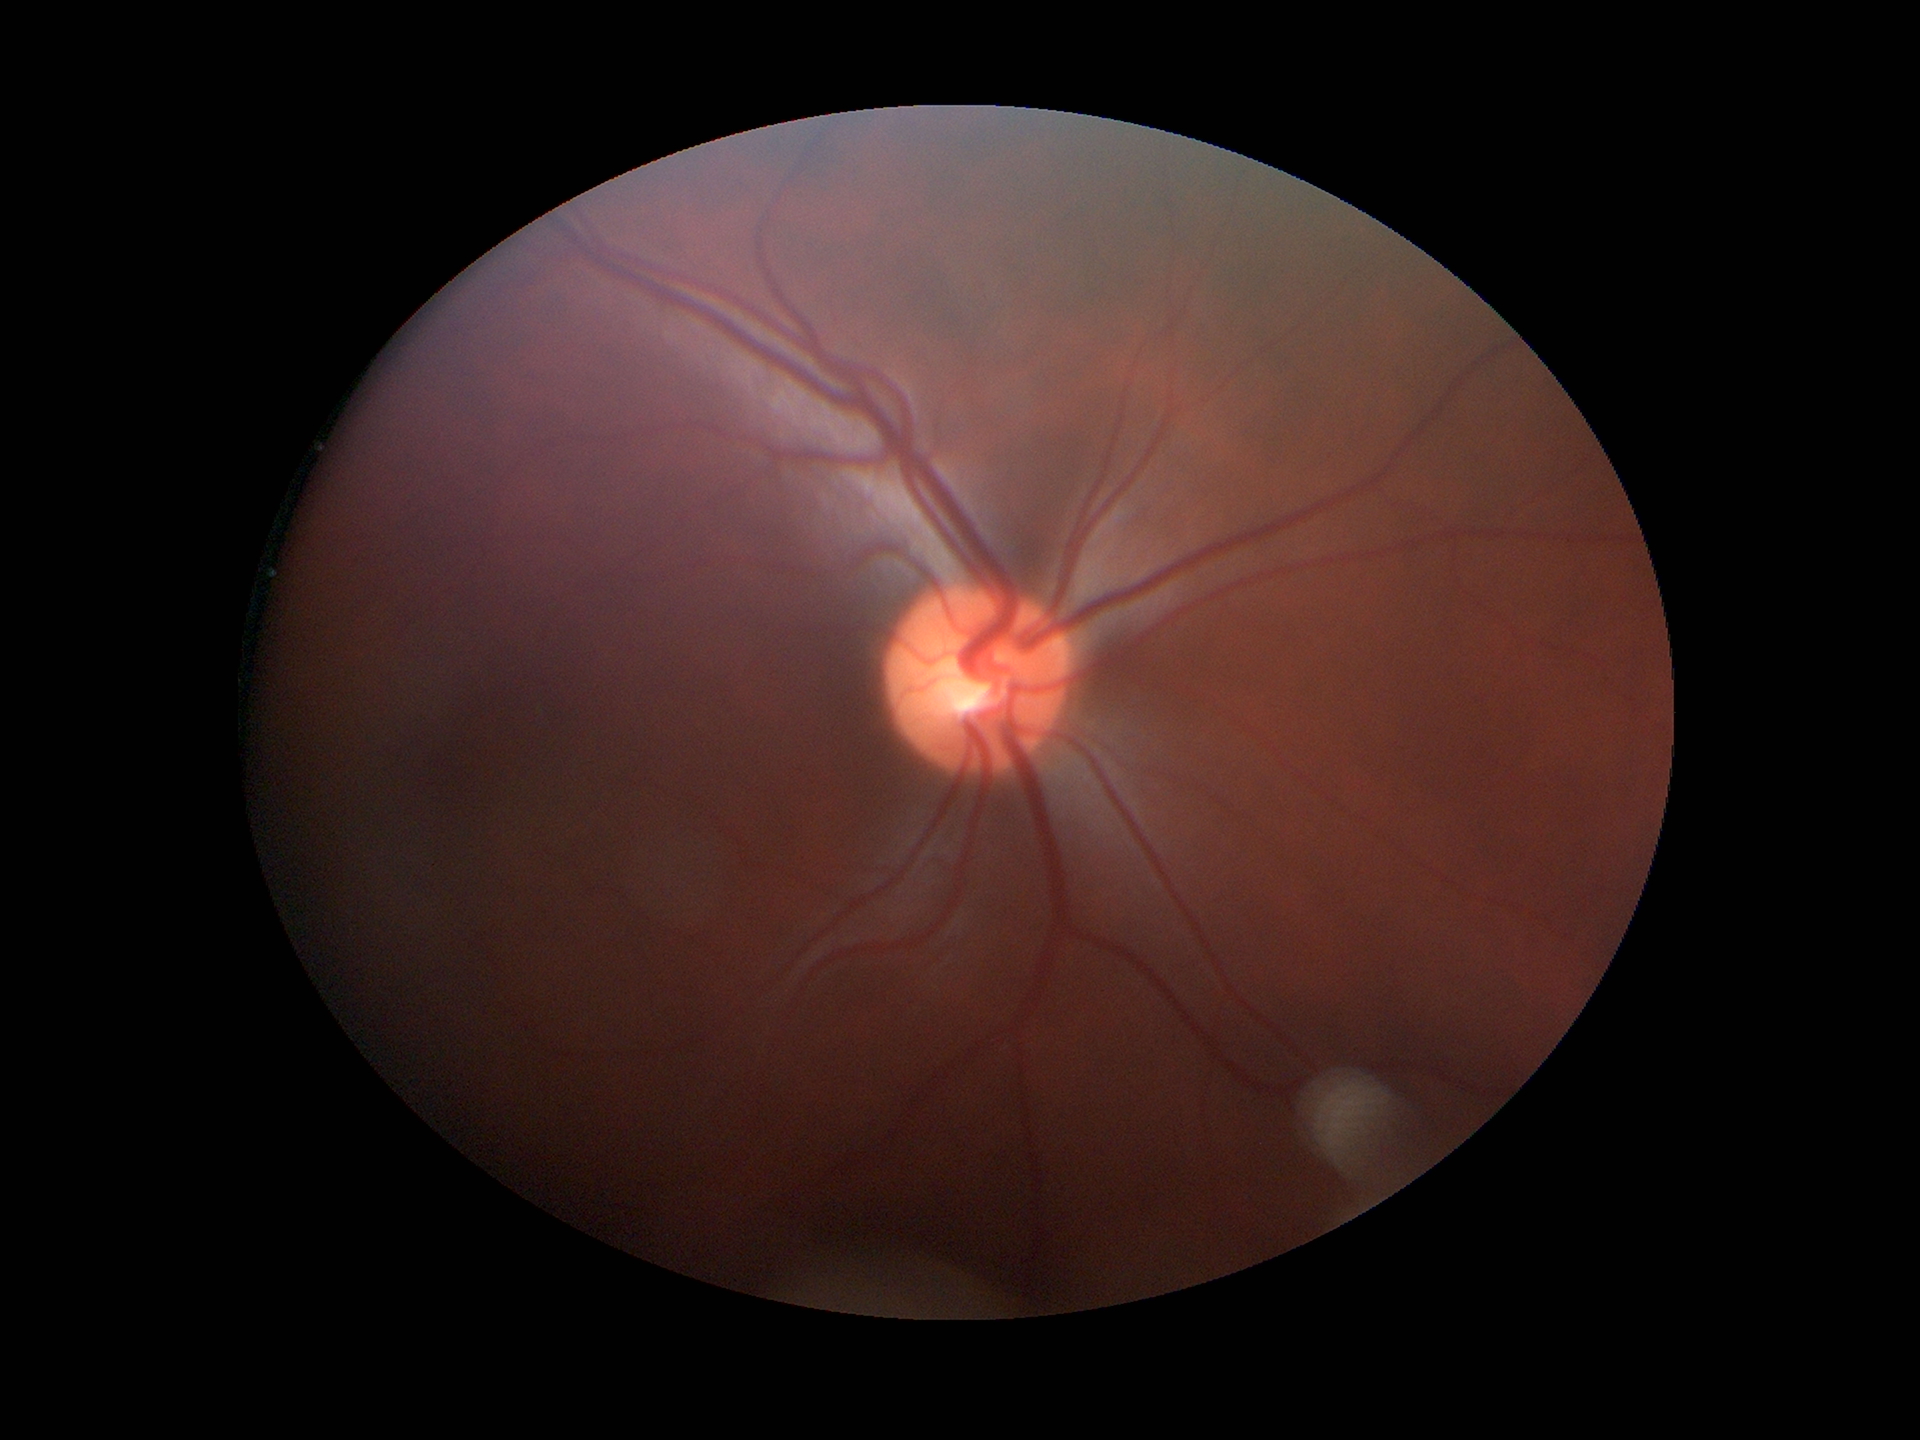 Glaucoma assessment: negative. Vertical CDR of 0.48. Horizontal C/D ratio: 0.49.